848x848px — 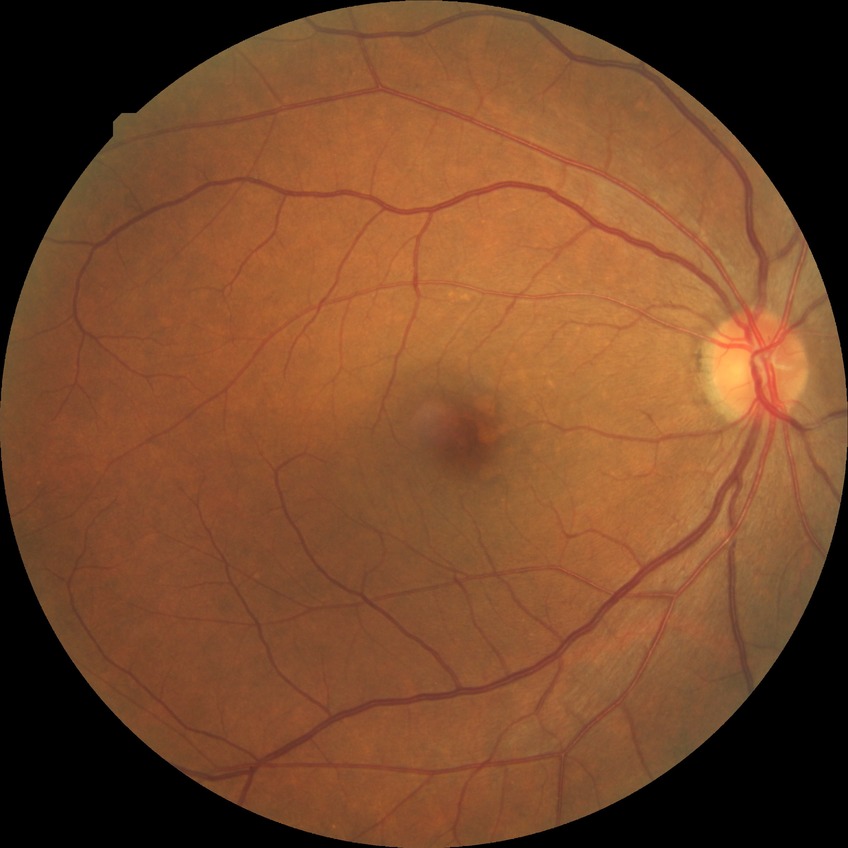 Findings:
– modified Davis grading: simple diabetic retinopathy